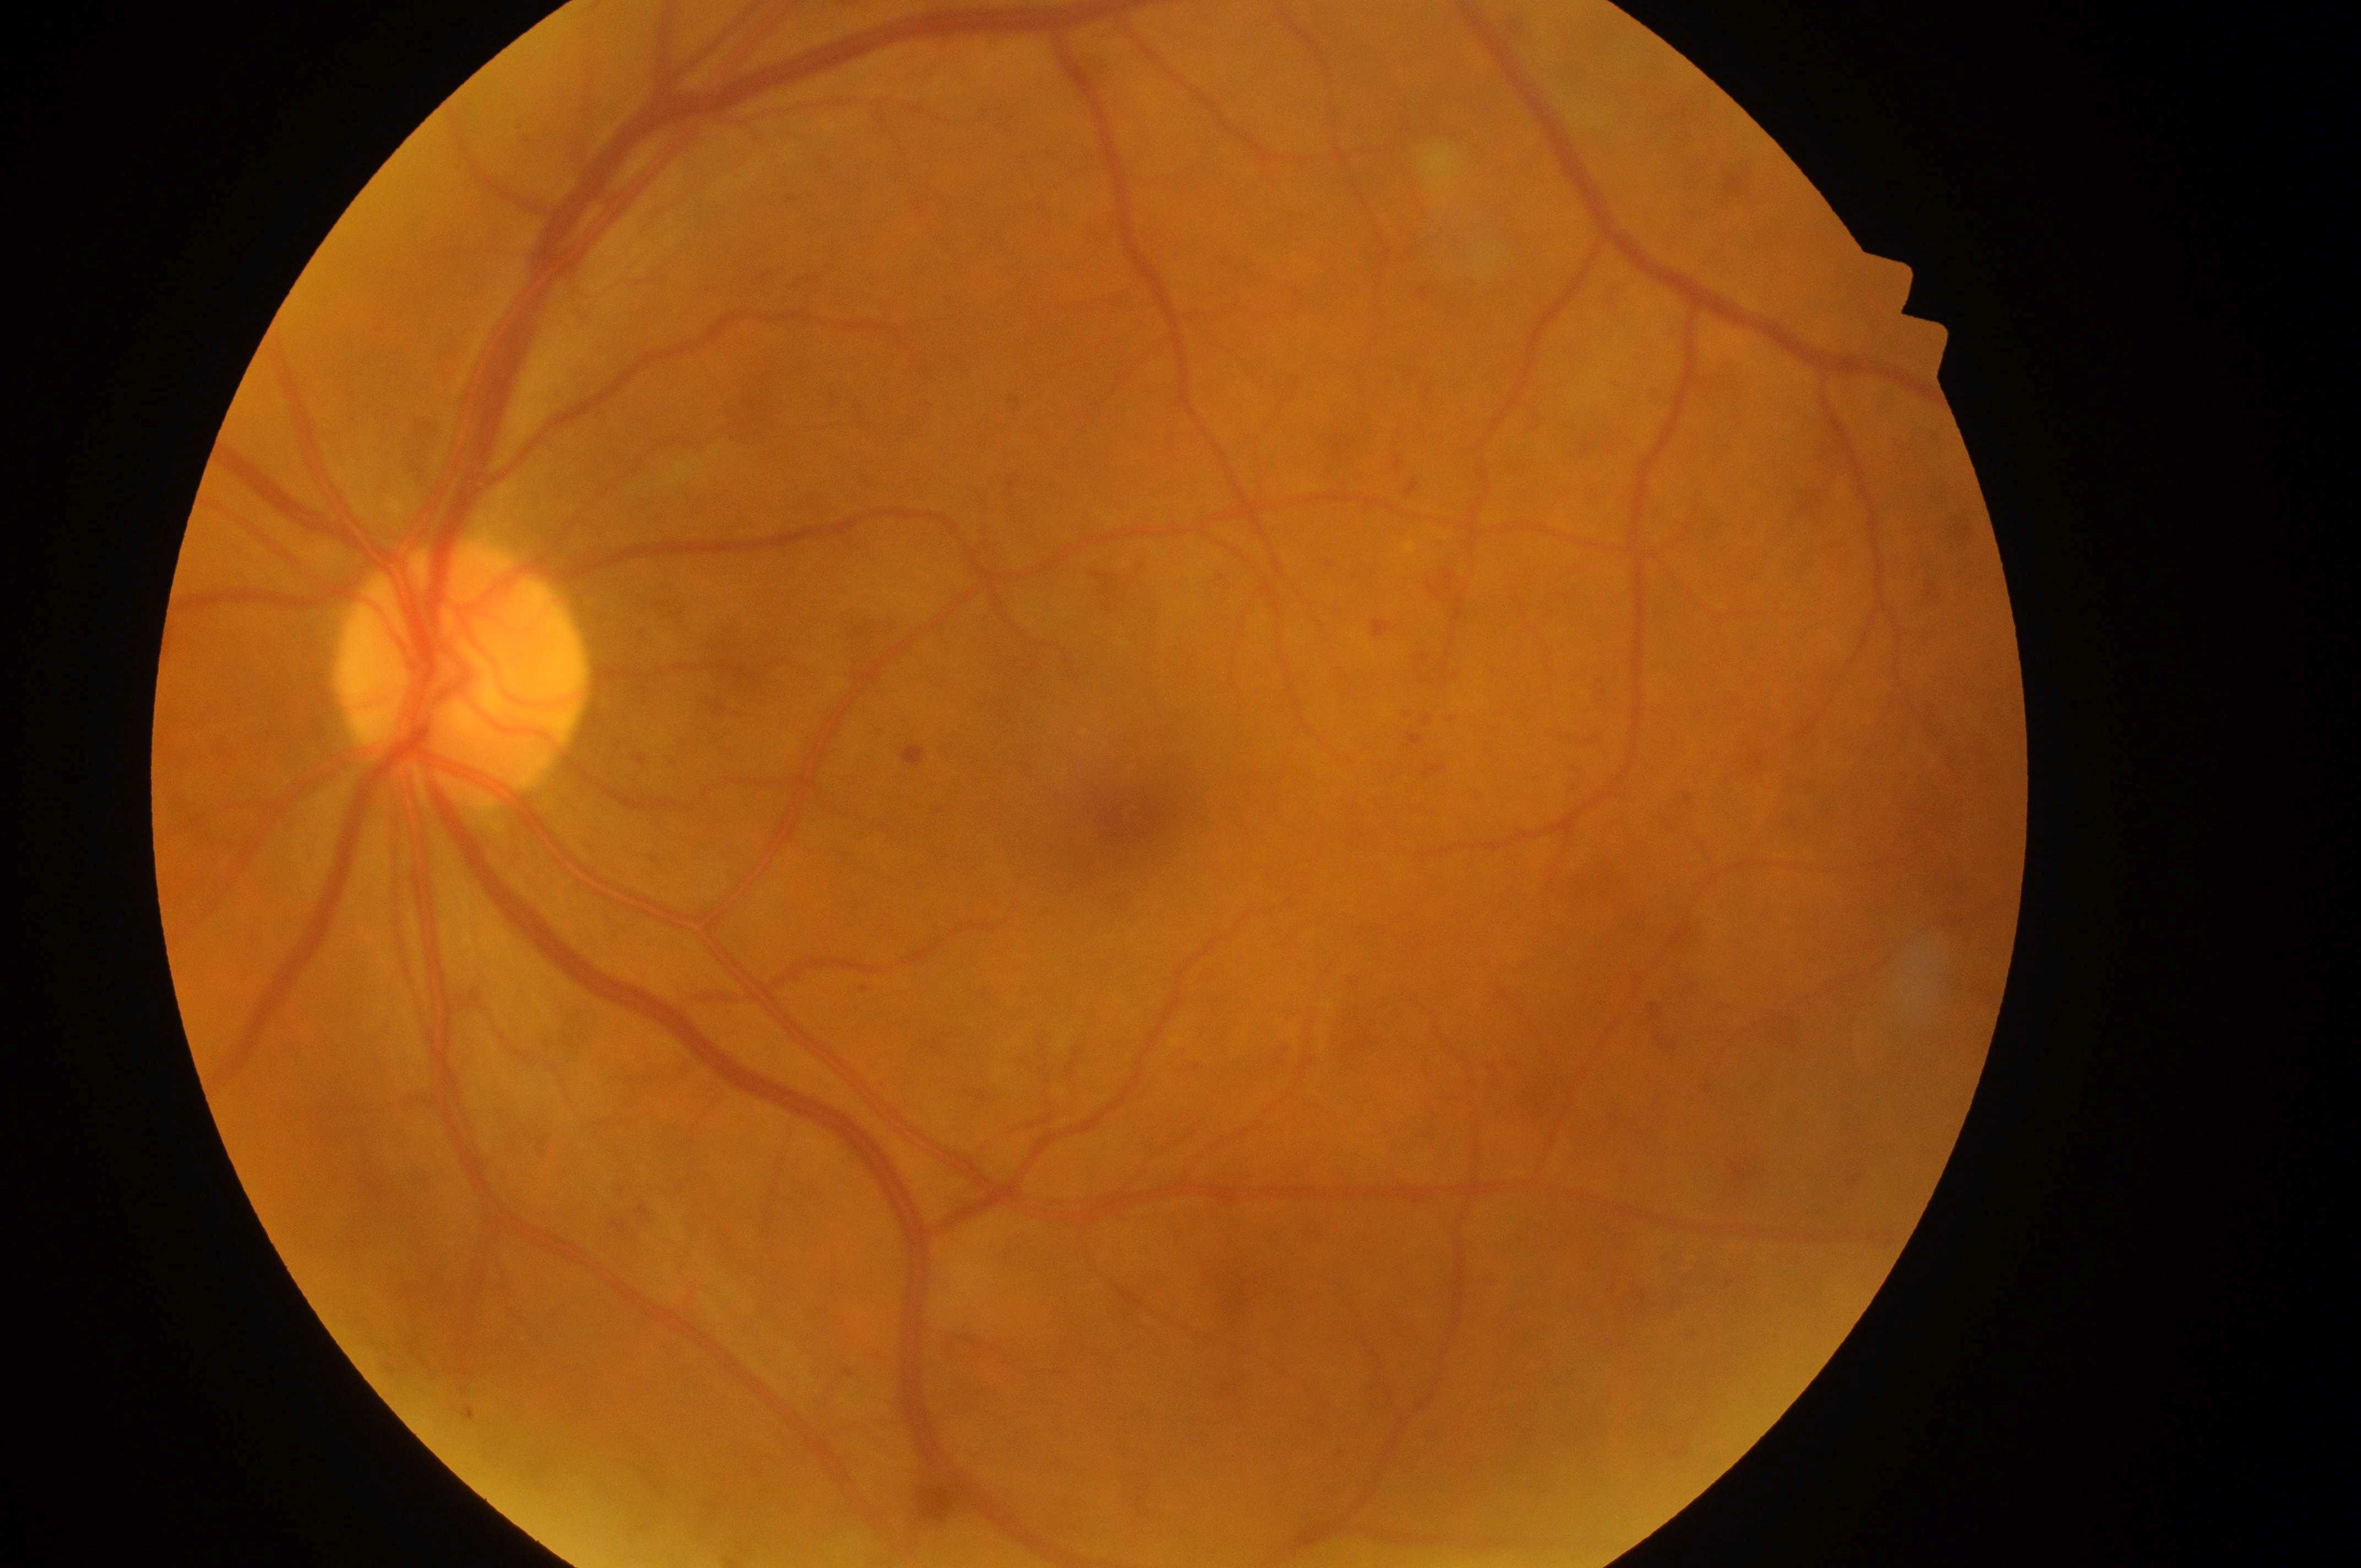
laterality = oculus sinister | fovea = 1136, 816 | DR severity = 2 | DME = grade 1 | optic disc center = 455, 682.